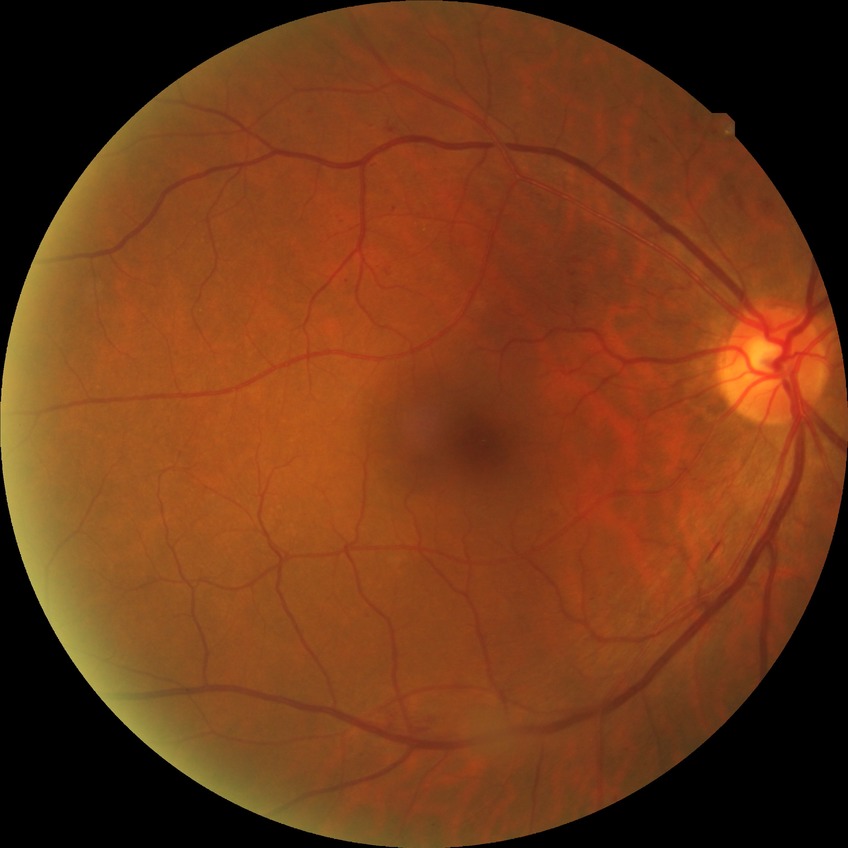

Annotations:
– DR class — non-proliferative diabetic retinopathy
– retinopathy grade — simple diabetic retinopathy